Pediatric wide-field fundus photograph.
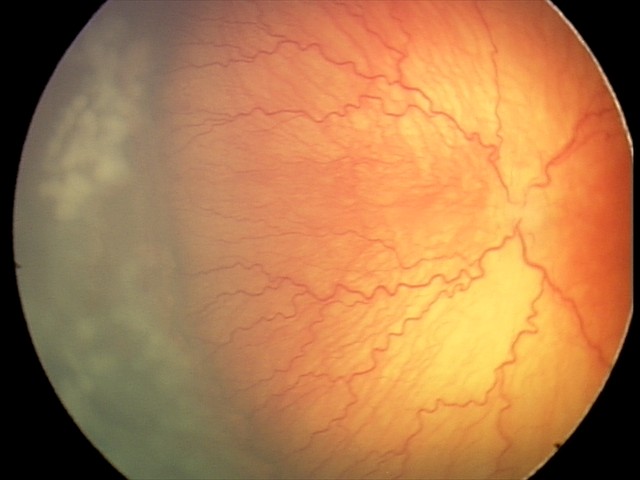 Series diagnosed as aggressive ROP (A-ROP).